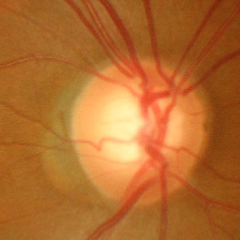
Glaucoma status: advanced glaucomatous optic neuropathy.